45° field of view; color fundus image
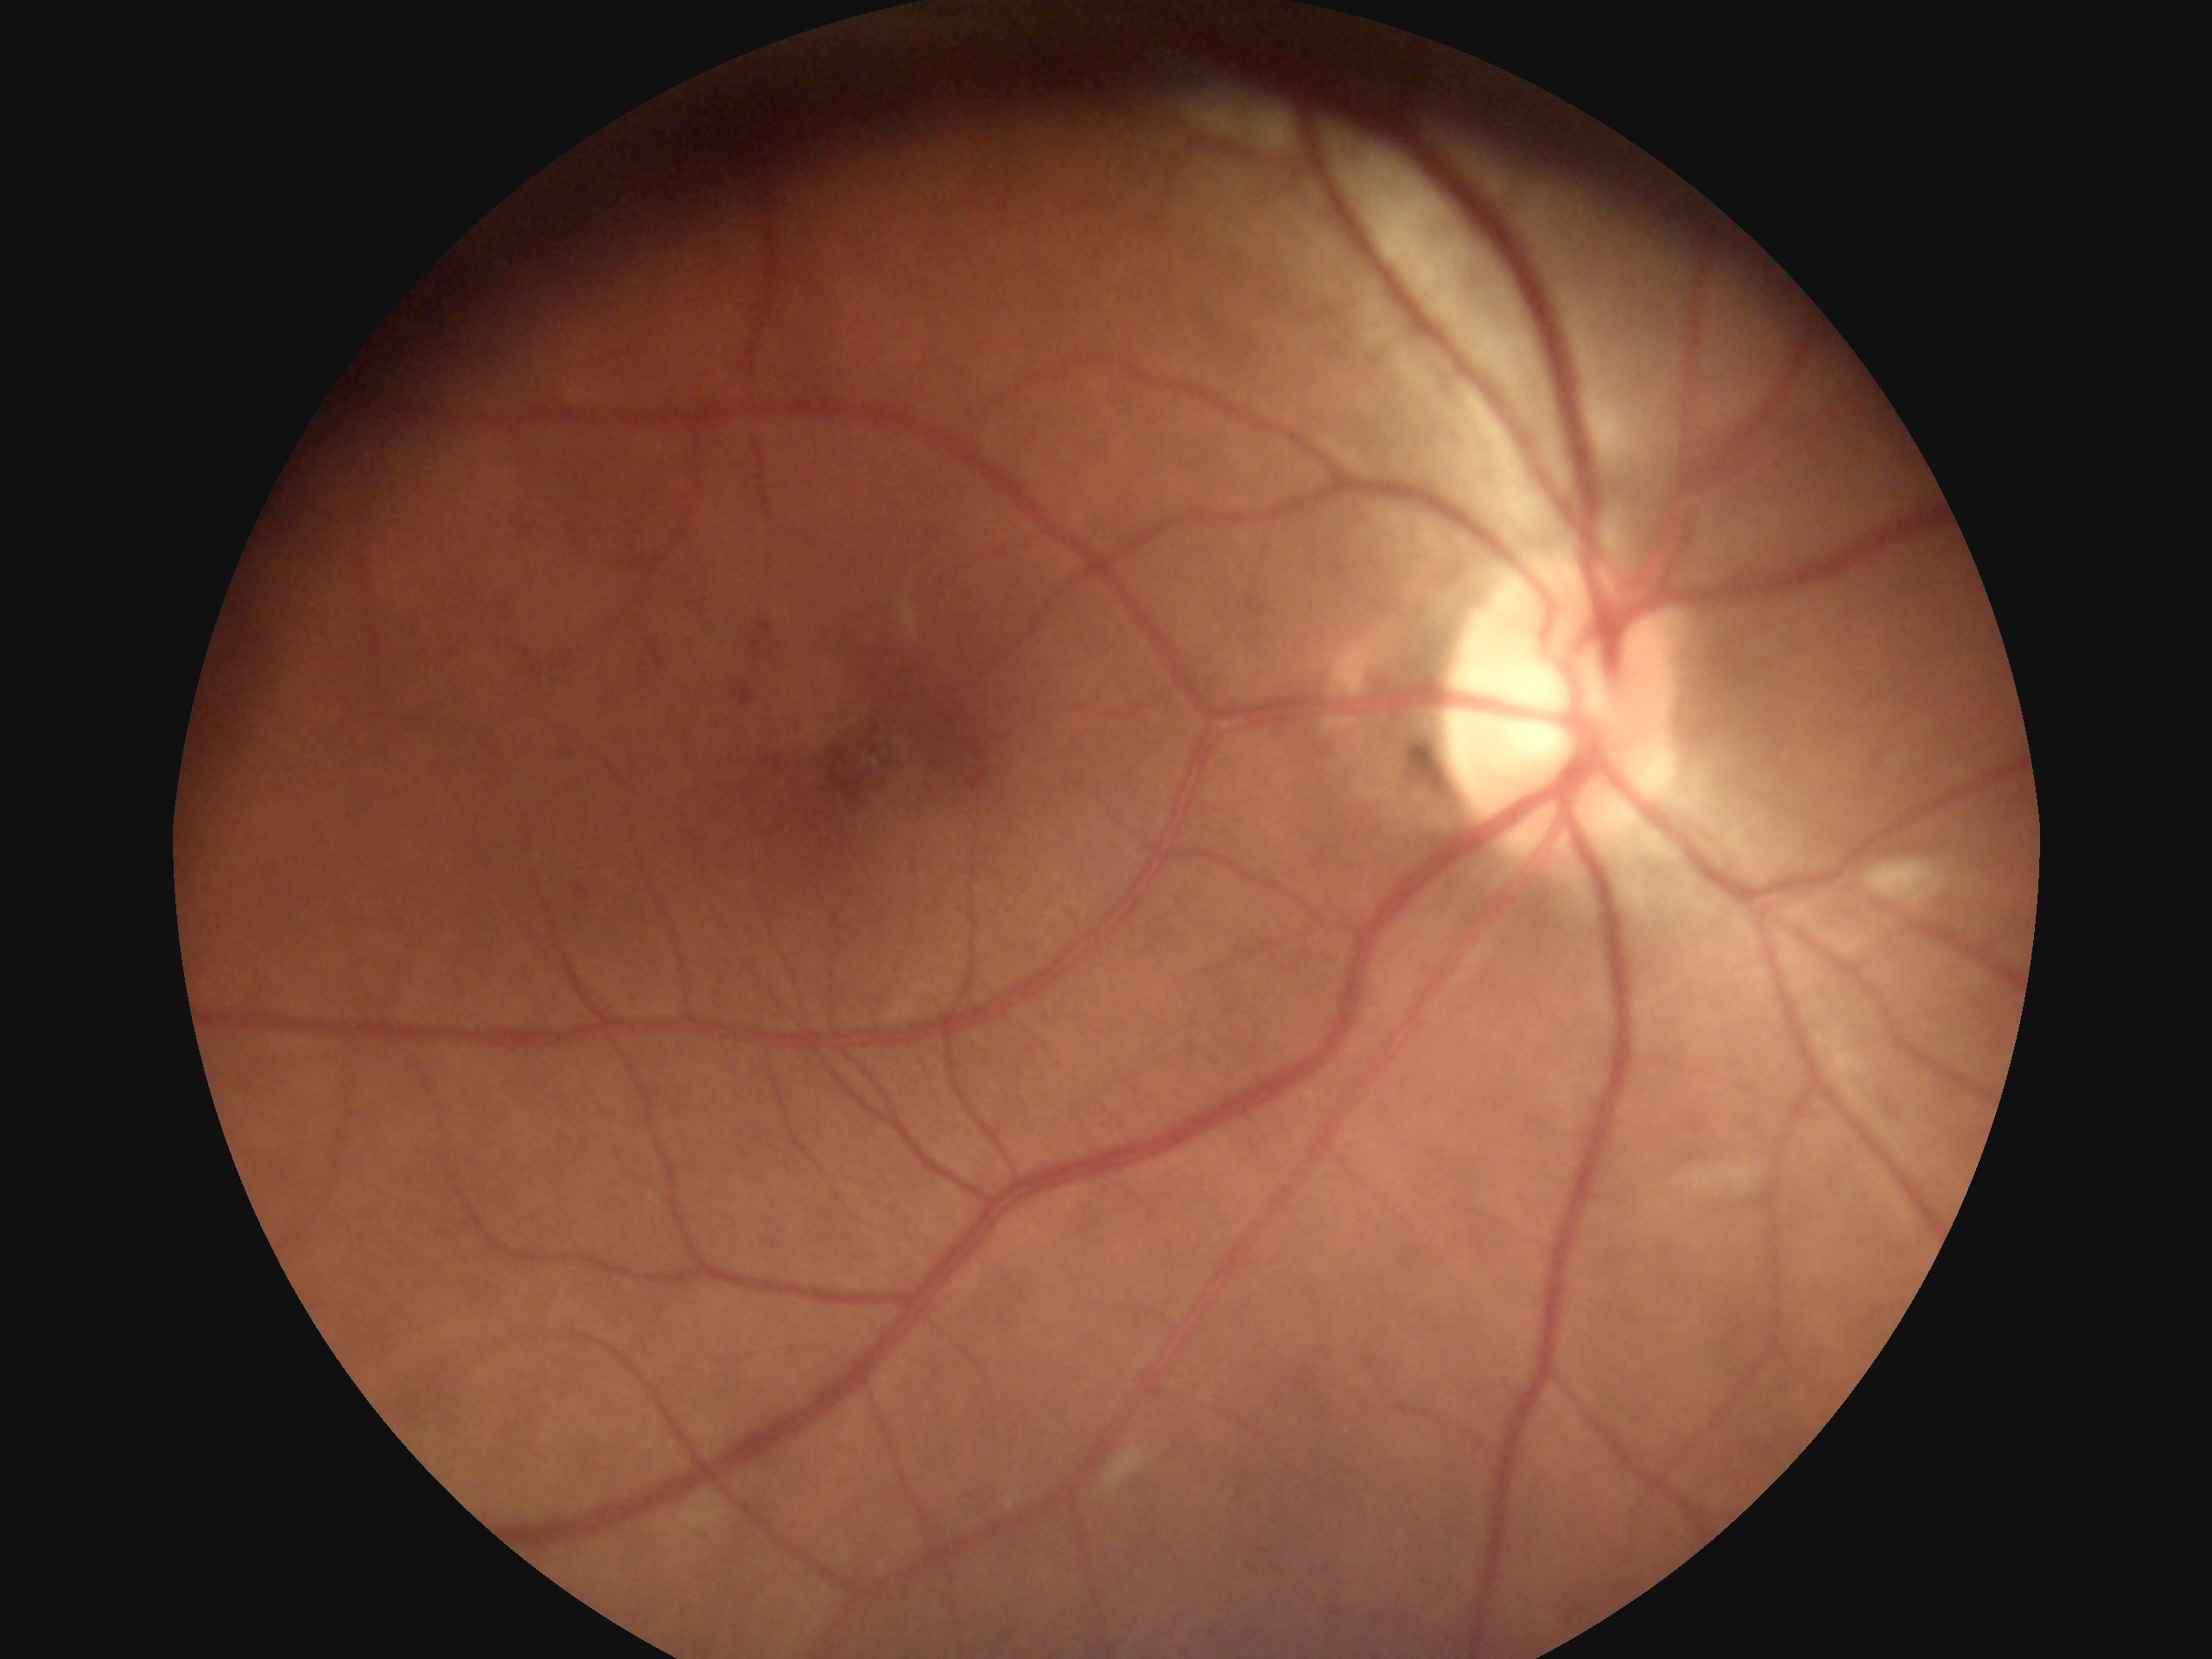

Findings:
* DR stage — 2